Retinal fundus photograph:
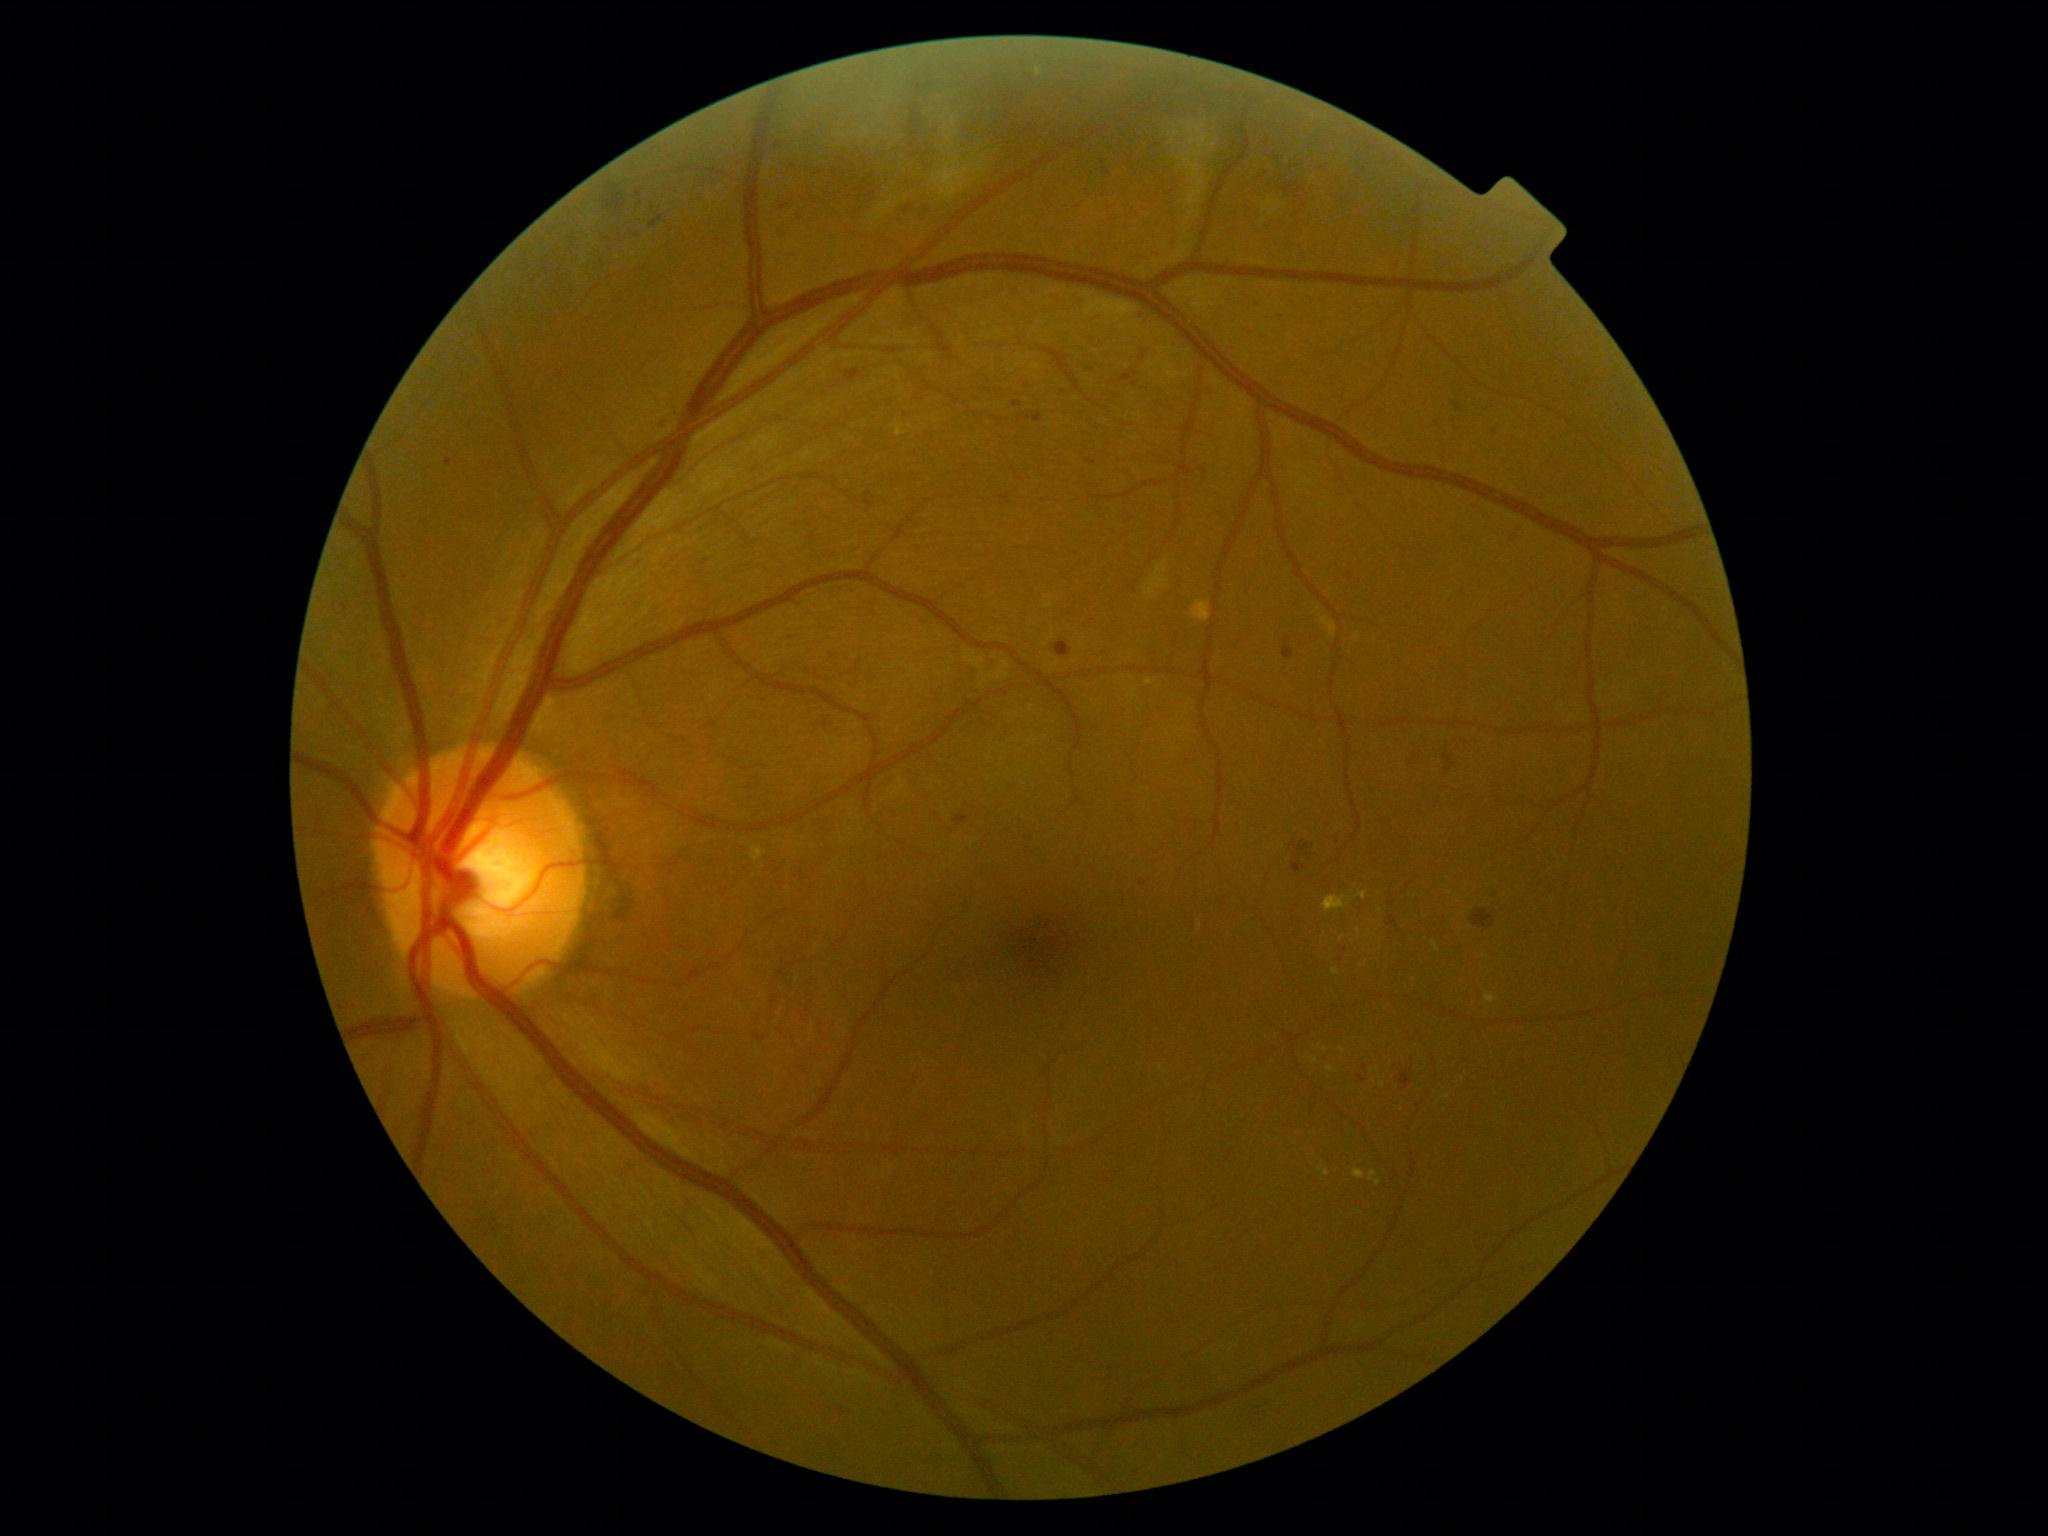
DR severity: 2/4.